Retinal fundus photograph. 1932 x 1910 pixels — 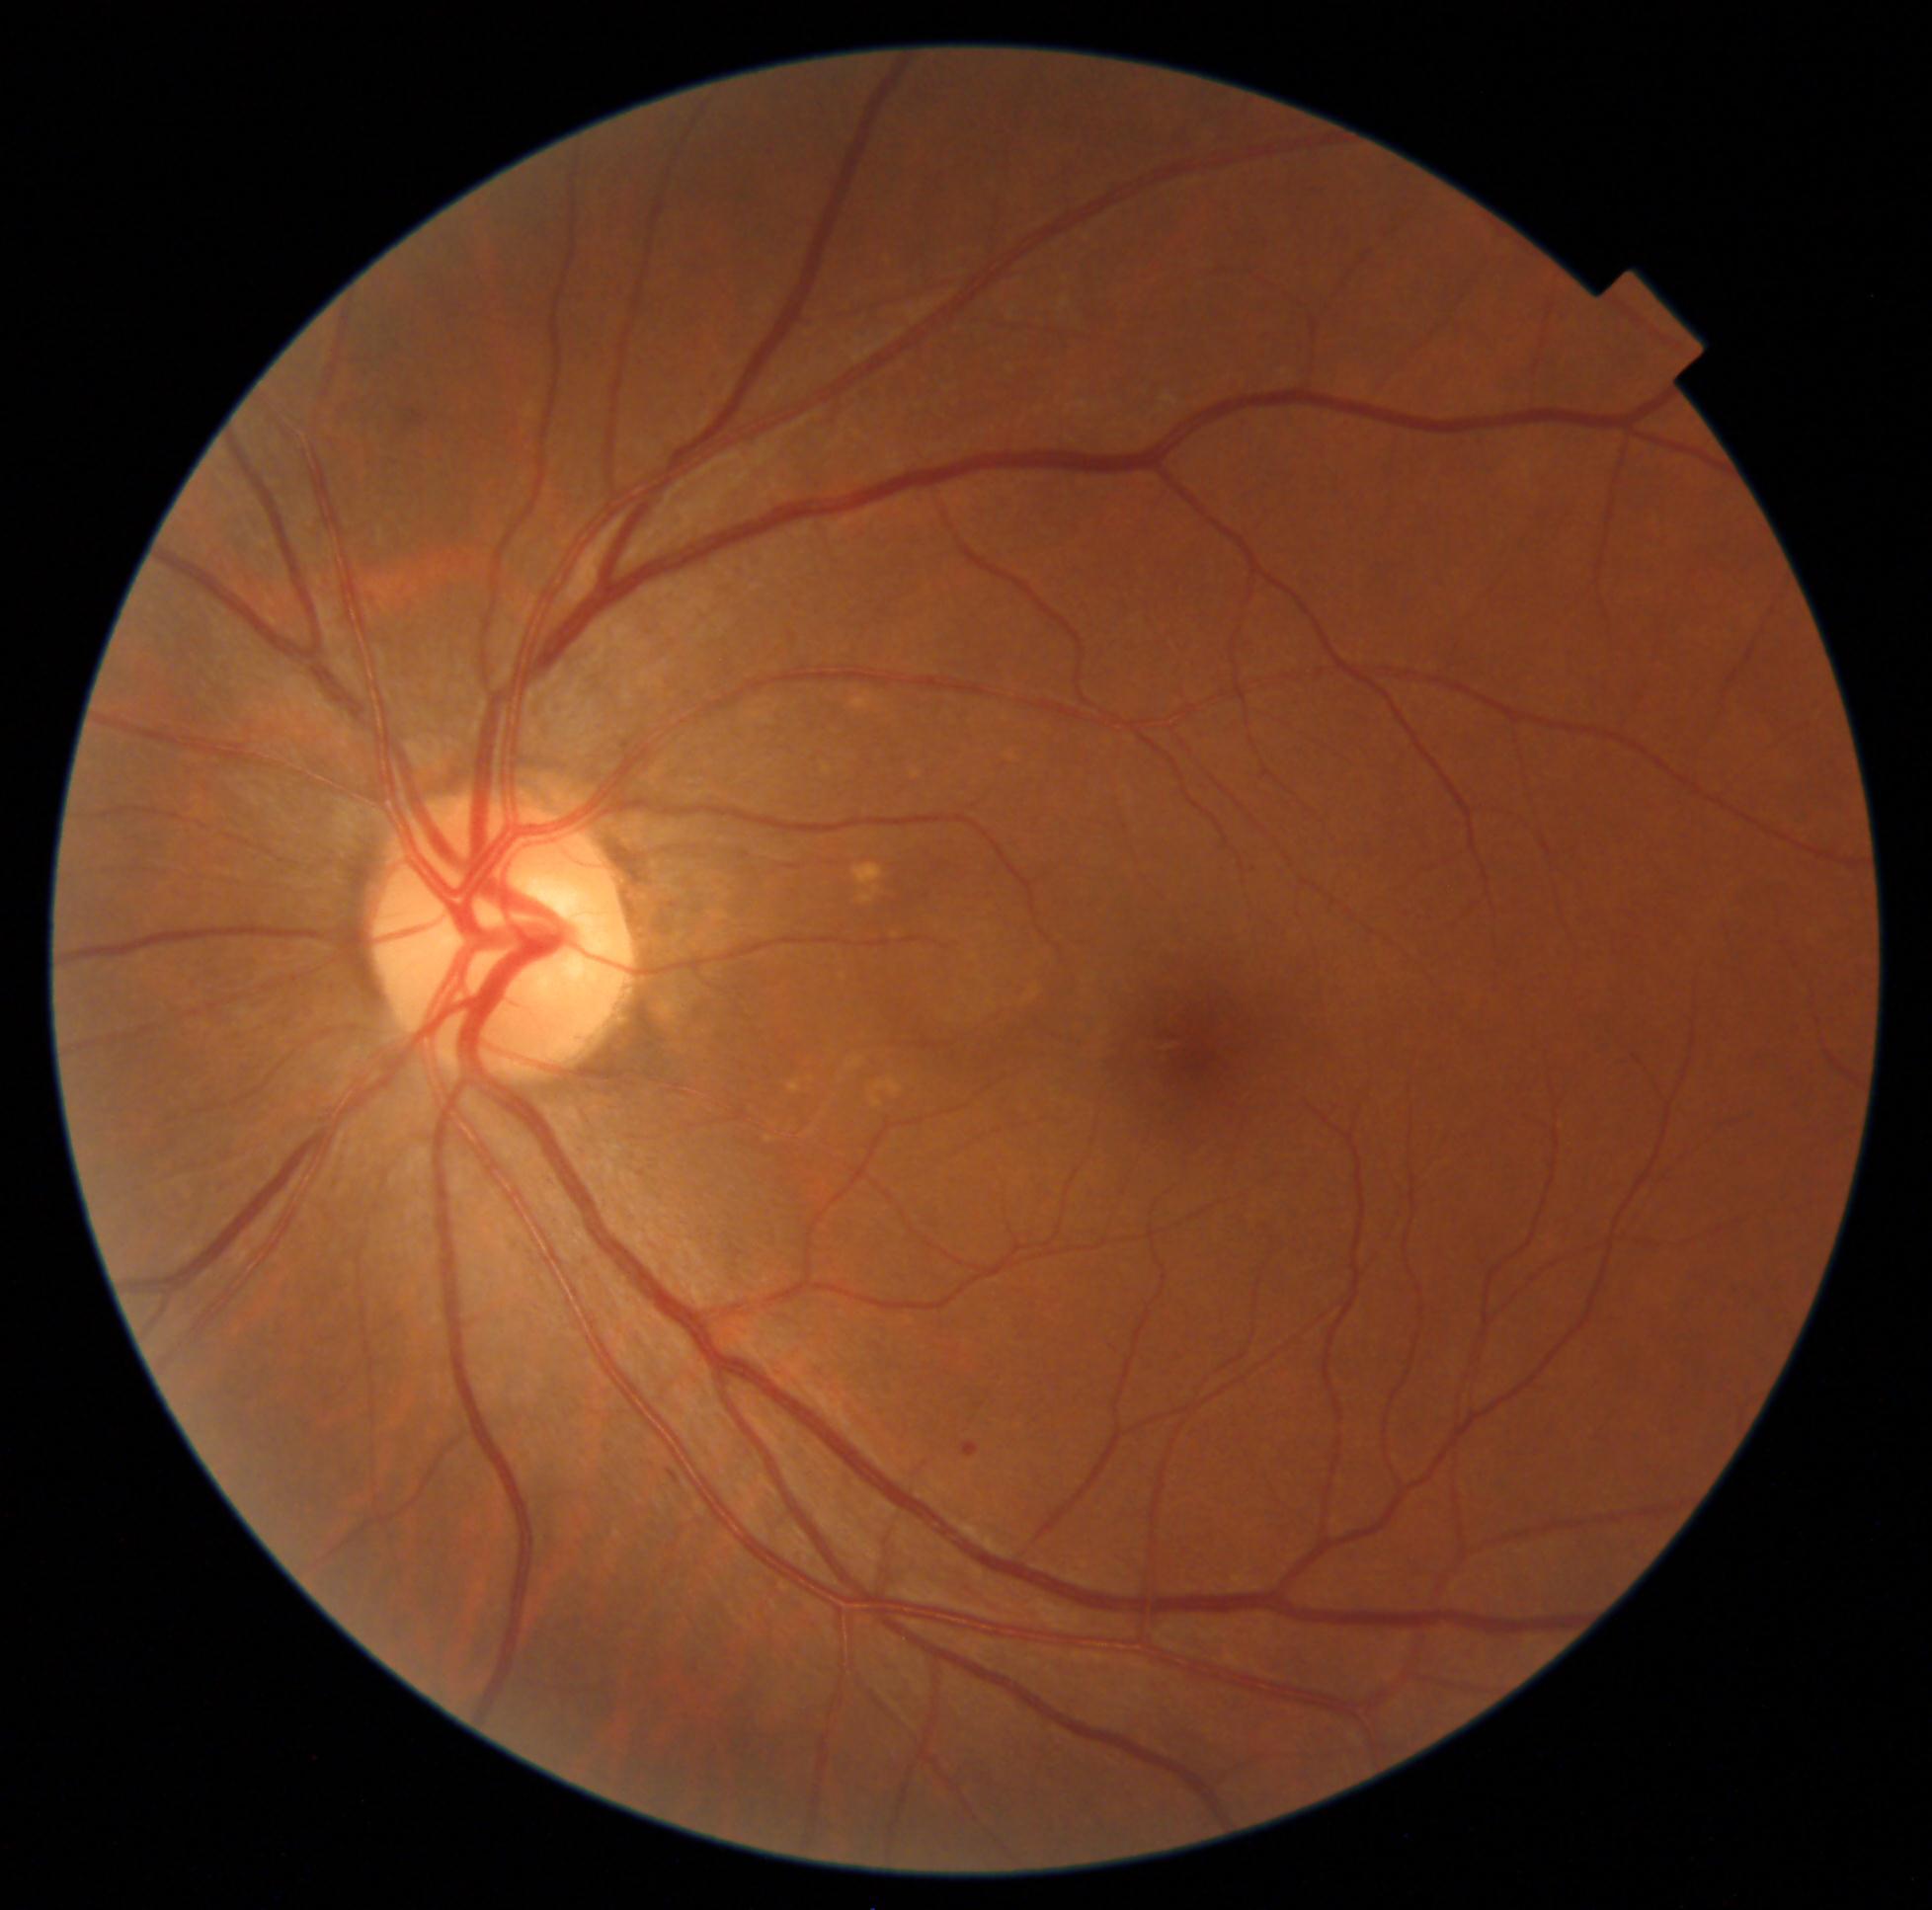

Diabetic retinopathy (DR) is mild NPDR (grade 1)
soft exudates (SEs) = none detected
microaneurysms (MAs) = {"x1": 962, "y1": 1442, "x2": 980, "y2": 1458}
hard exudates (EXs) = none detected
hemorrhages (HEs) = none detected